Pediatric retinal photograph (wide-field)
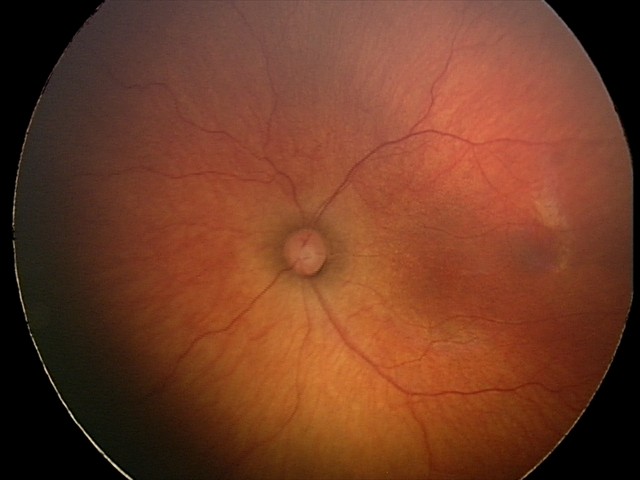

Screening: status post ROP.